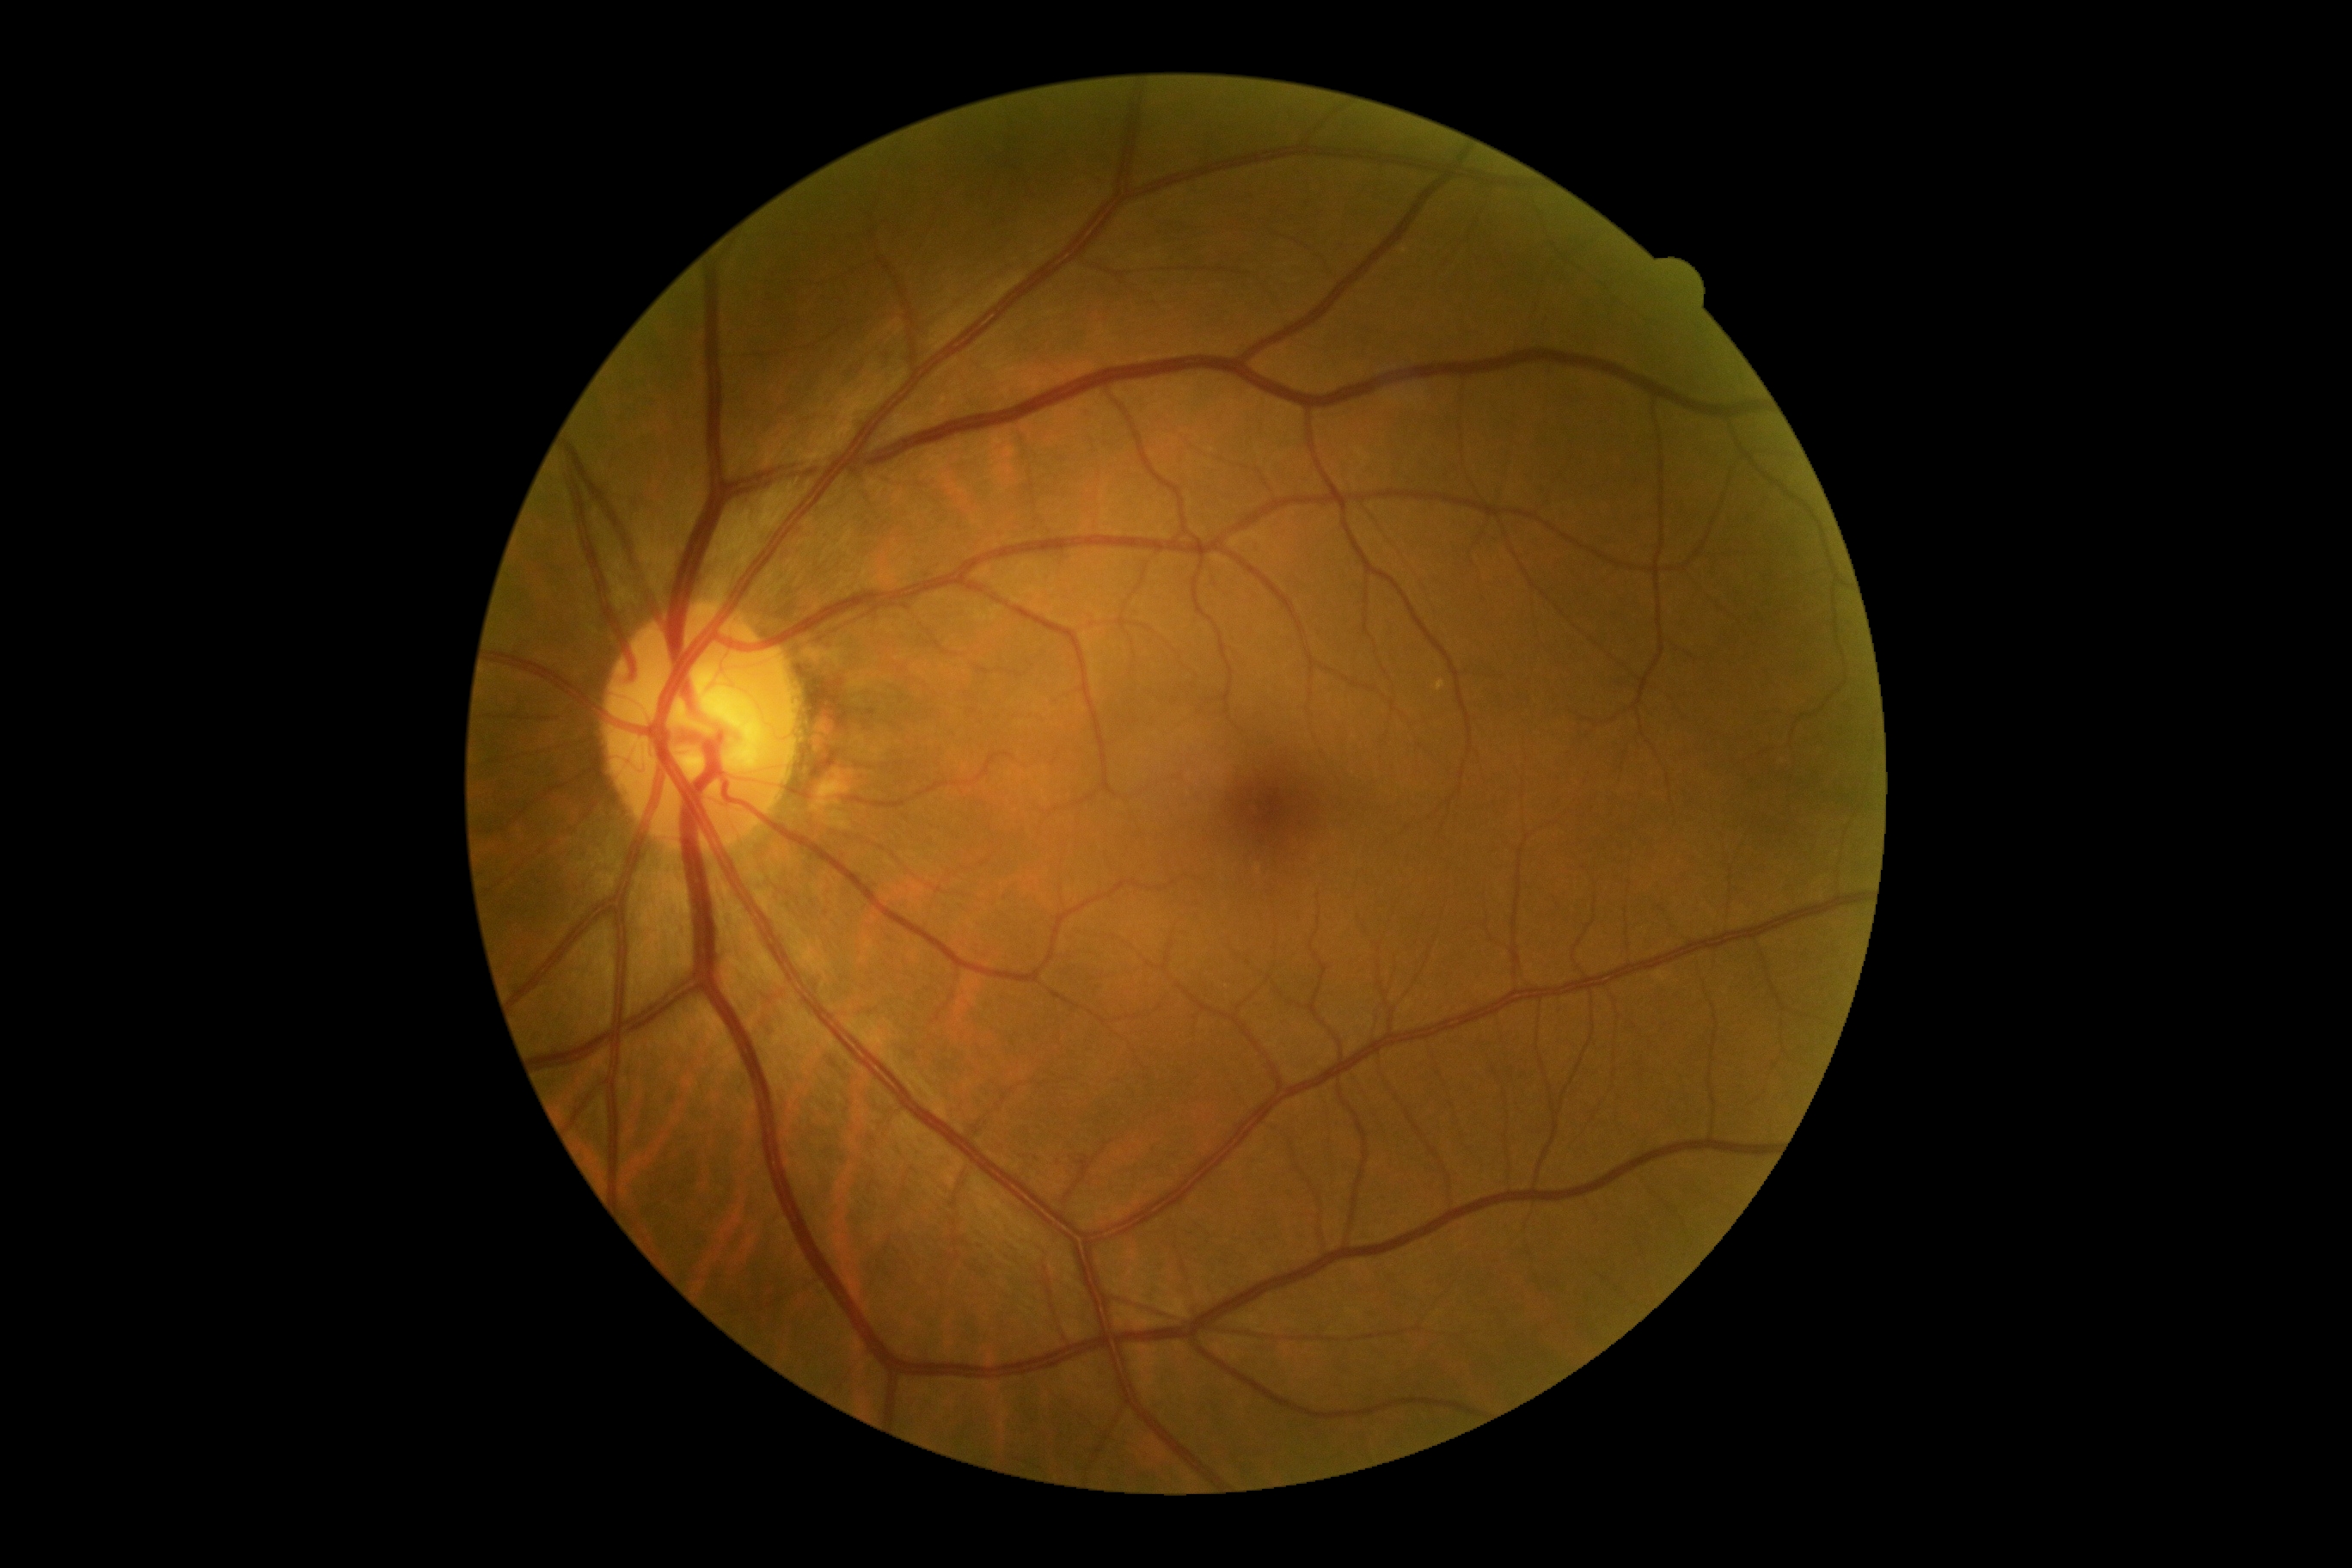
diabetic retinopathy: grade 0 (no apparent retinopathy).